2352x1568
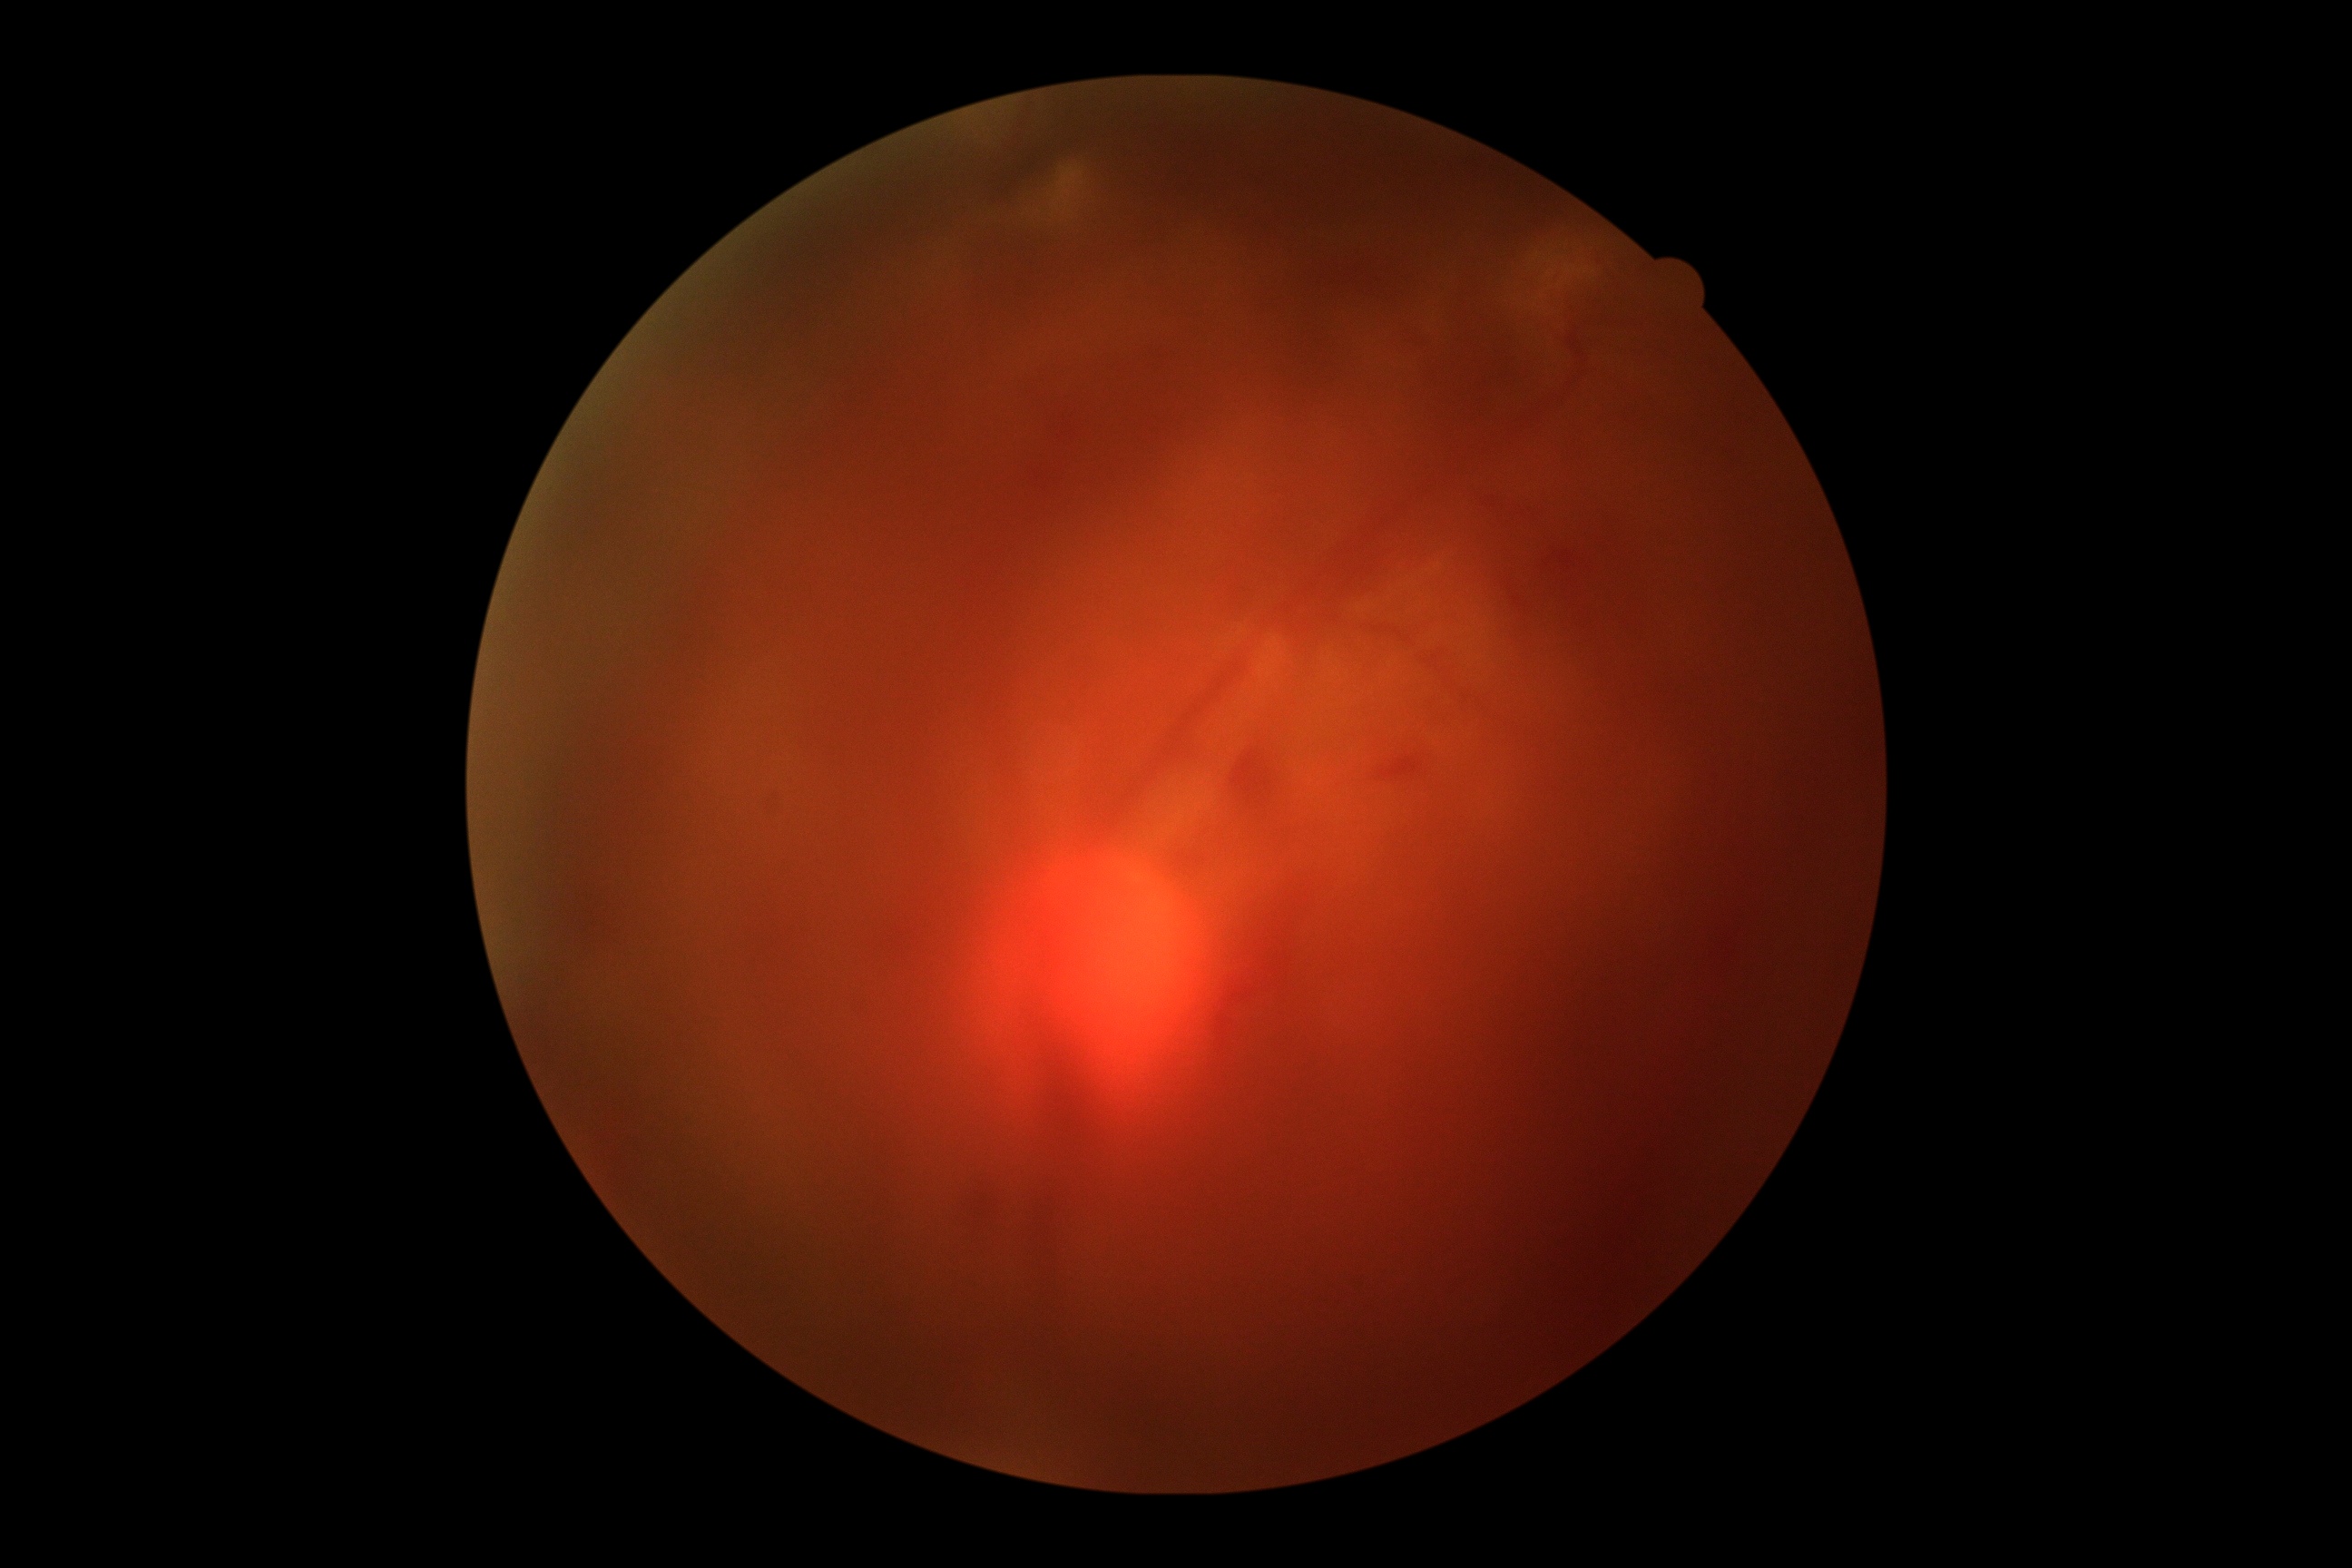

Quality: poor. Proliferative diabetic retinopathy: suspected, not confirmed.